CFP: 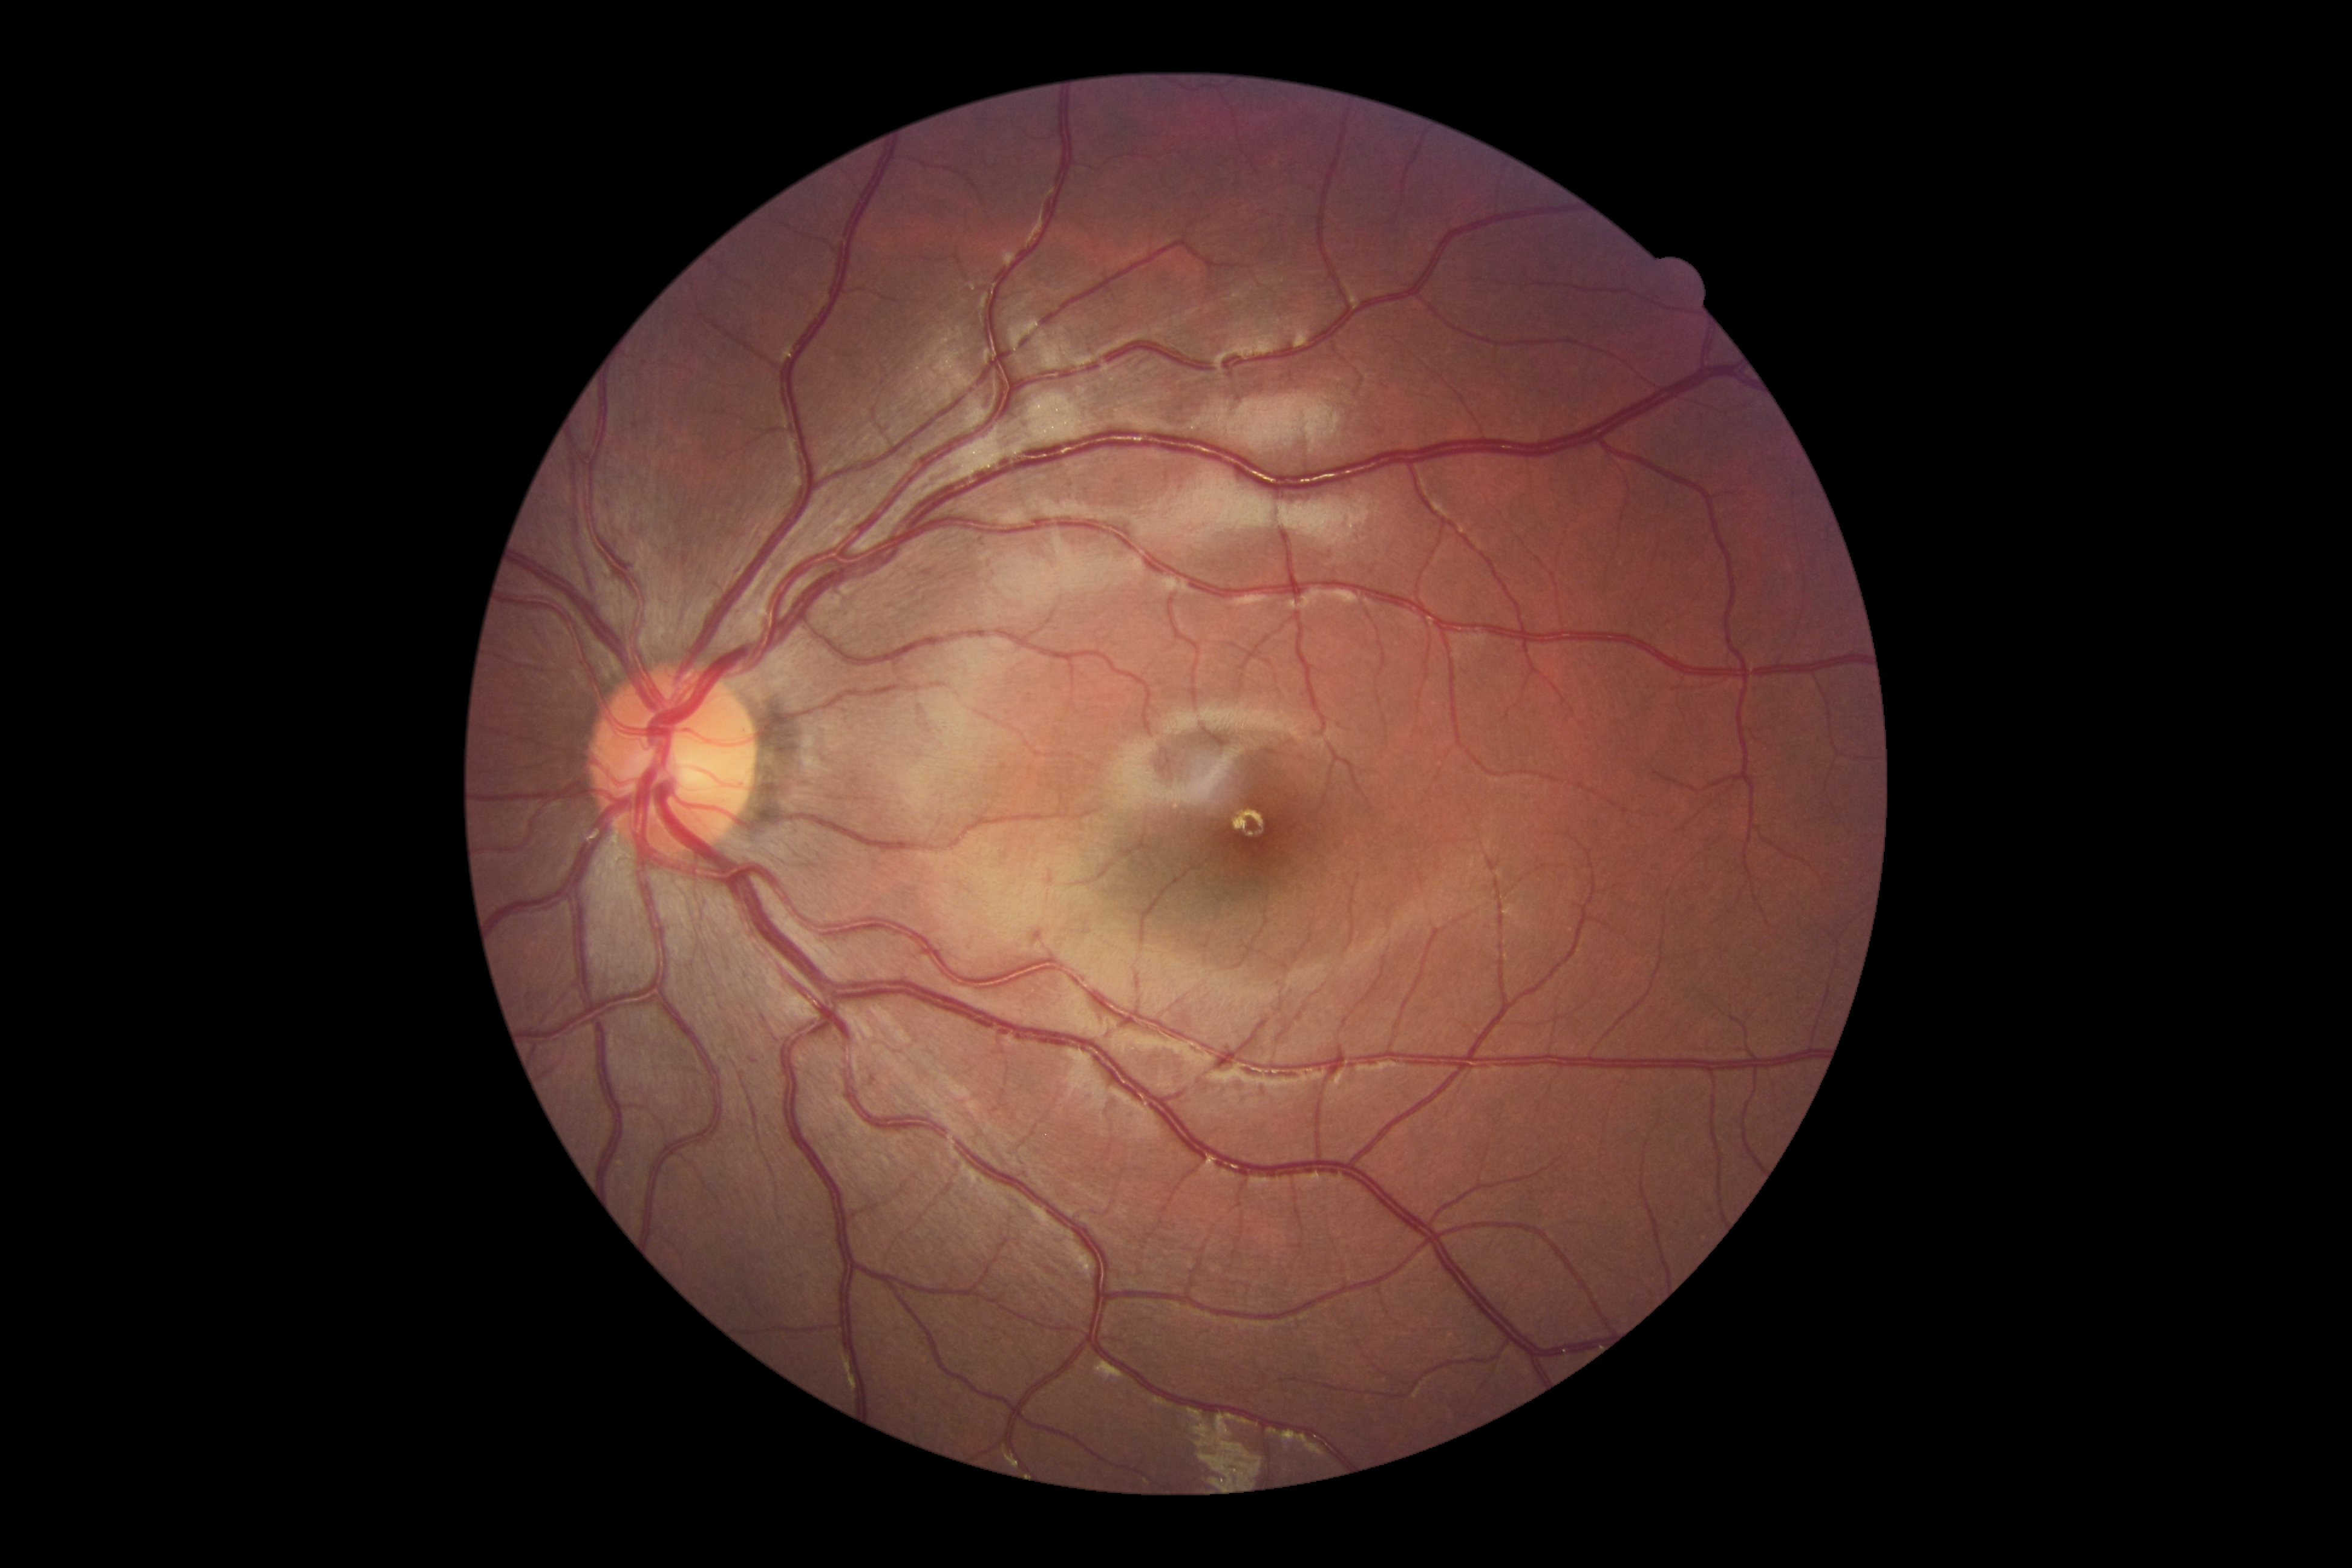

Diabetic retinopathy (DR) is 0/4.
No signs of diabetic retinopathy.